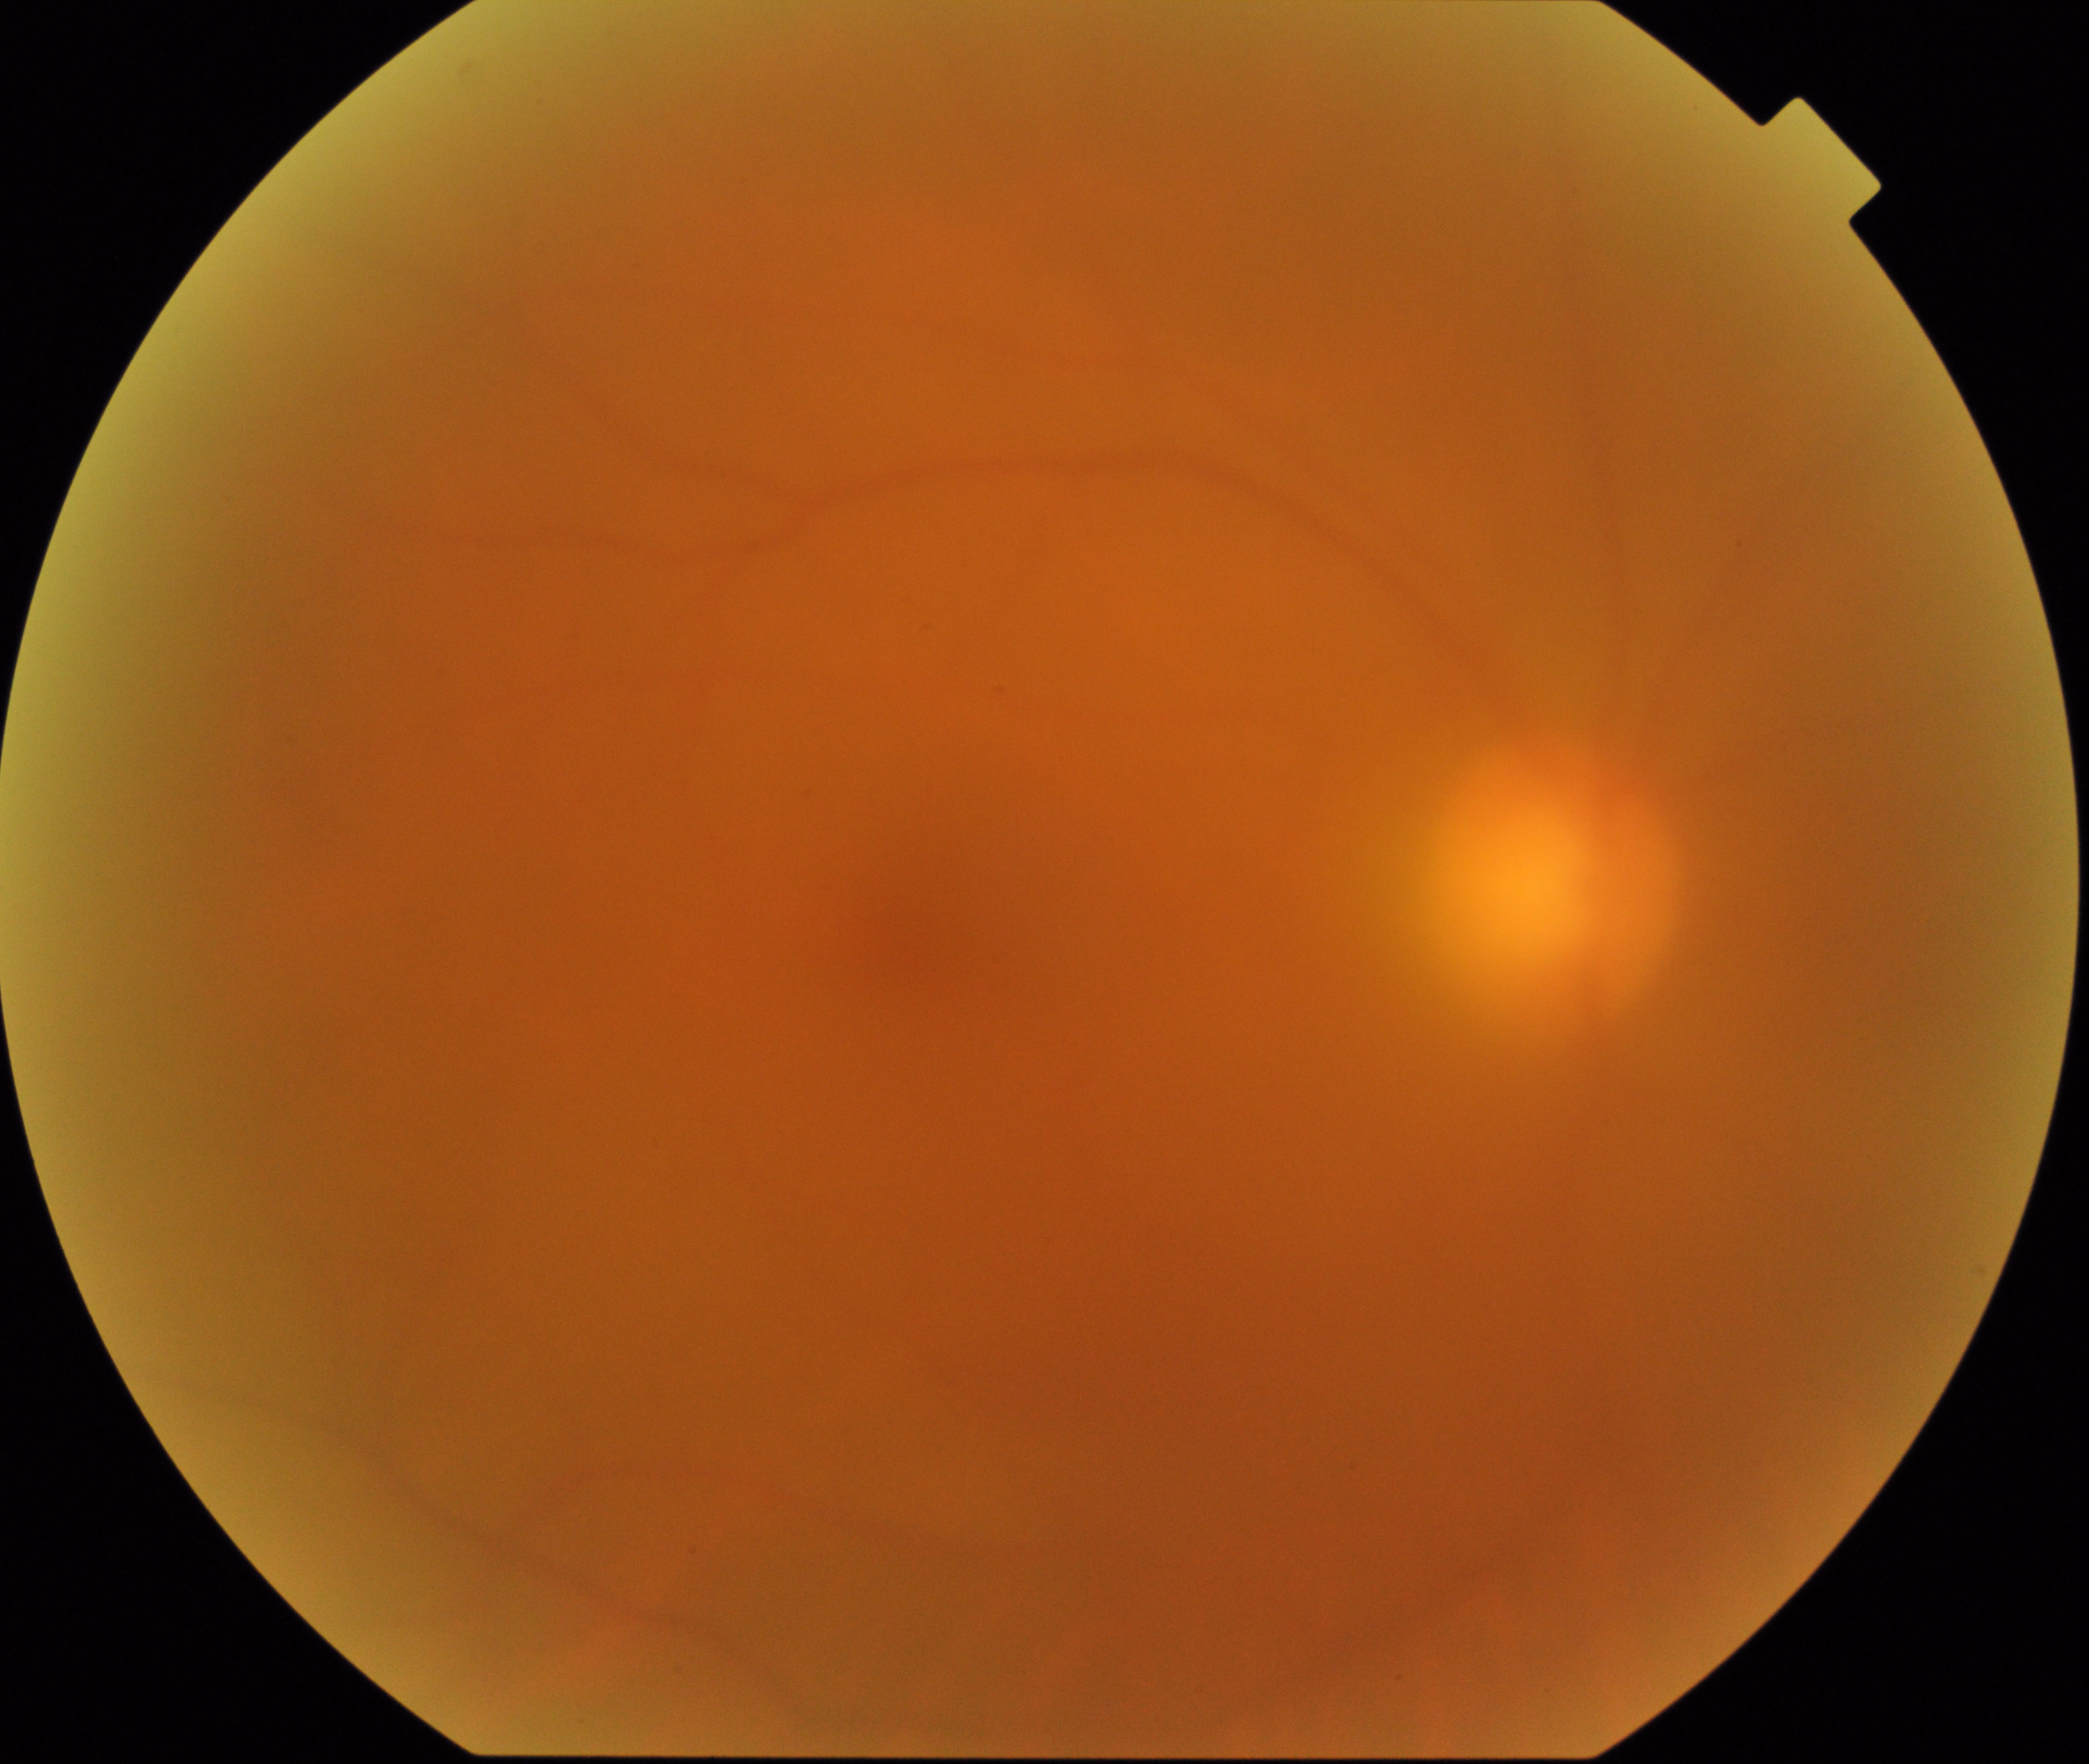

Significantly degraded image quality with obscured retinal detail. No proliferative diabetic retinopathy identified.